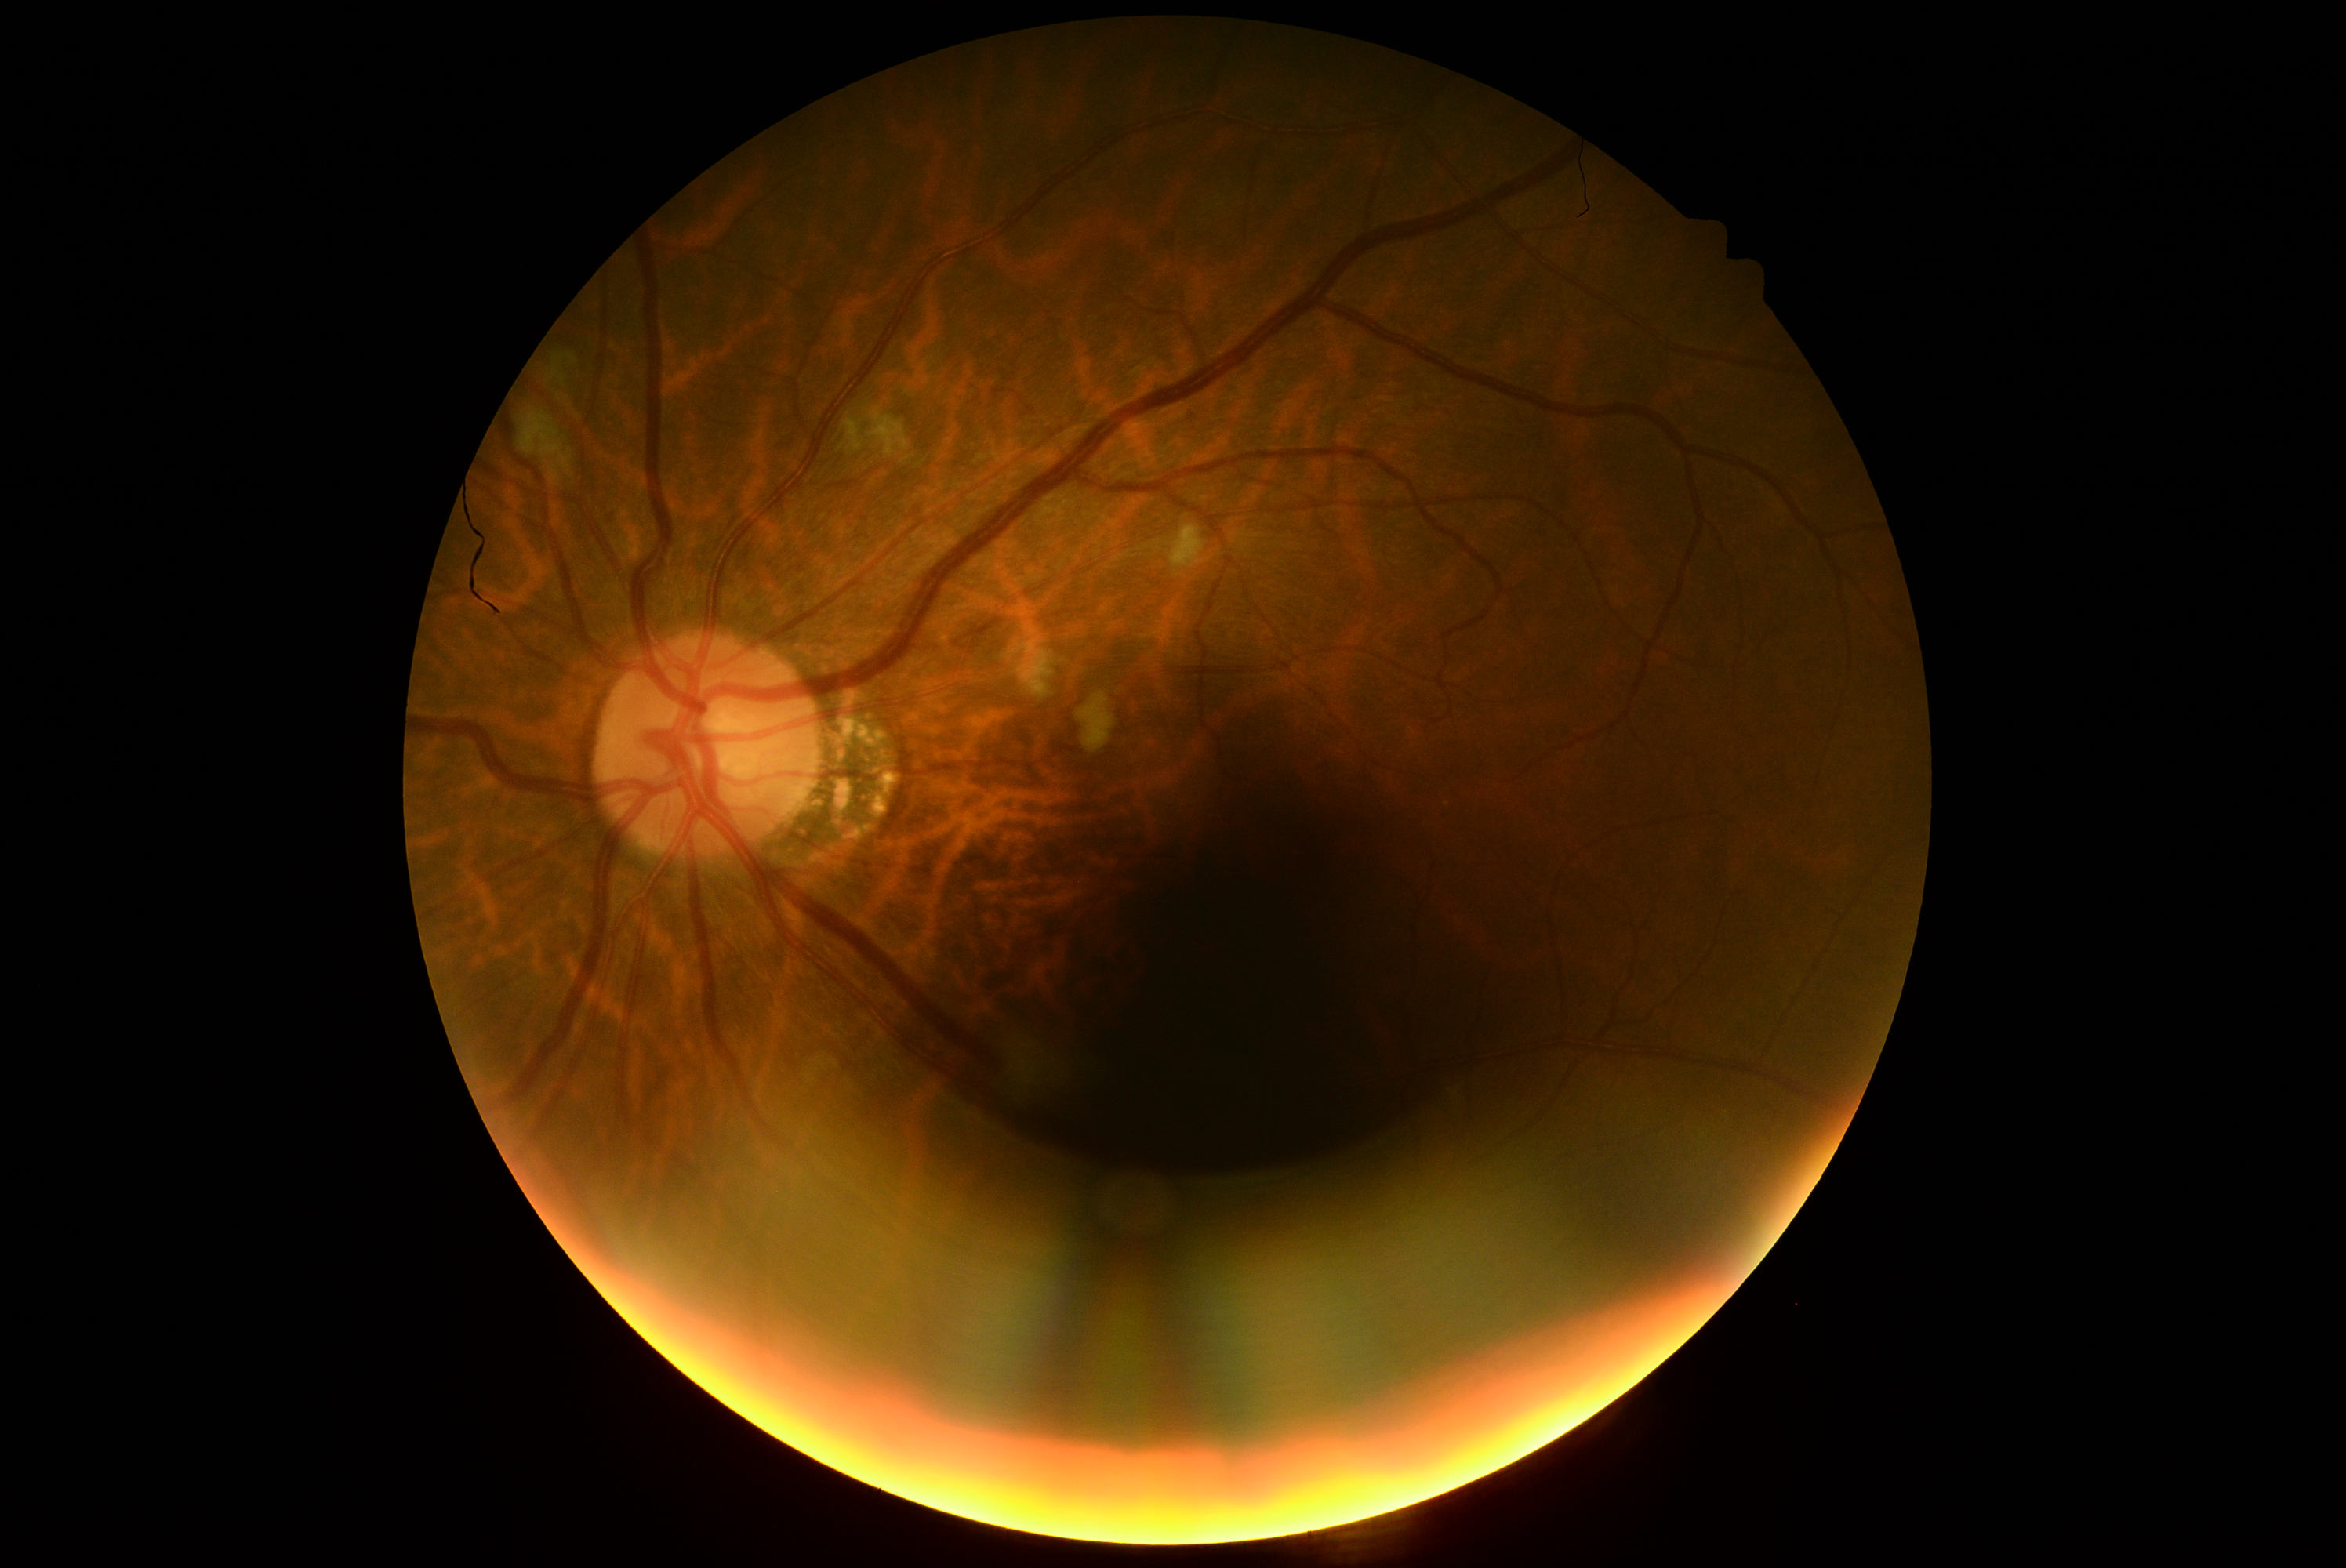
Retinopathy: 2/4.